Color fundus photograph · 50° FOV · 1924x1556px: 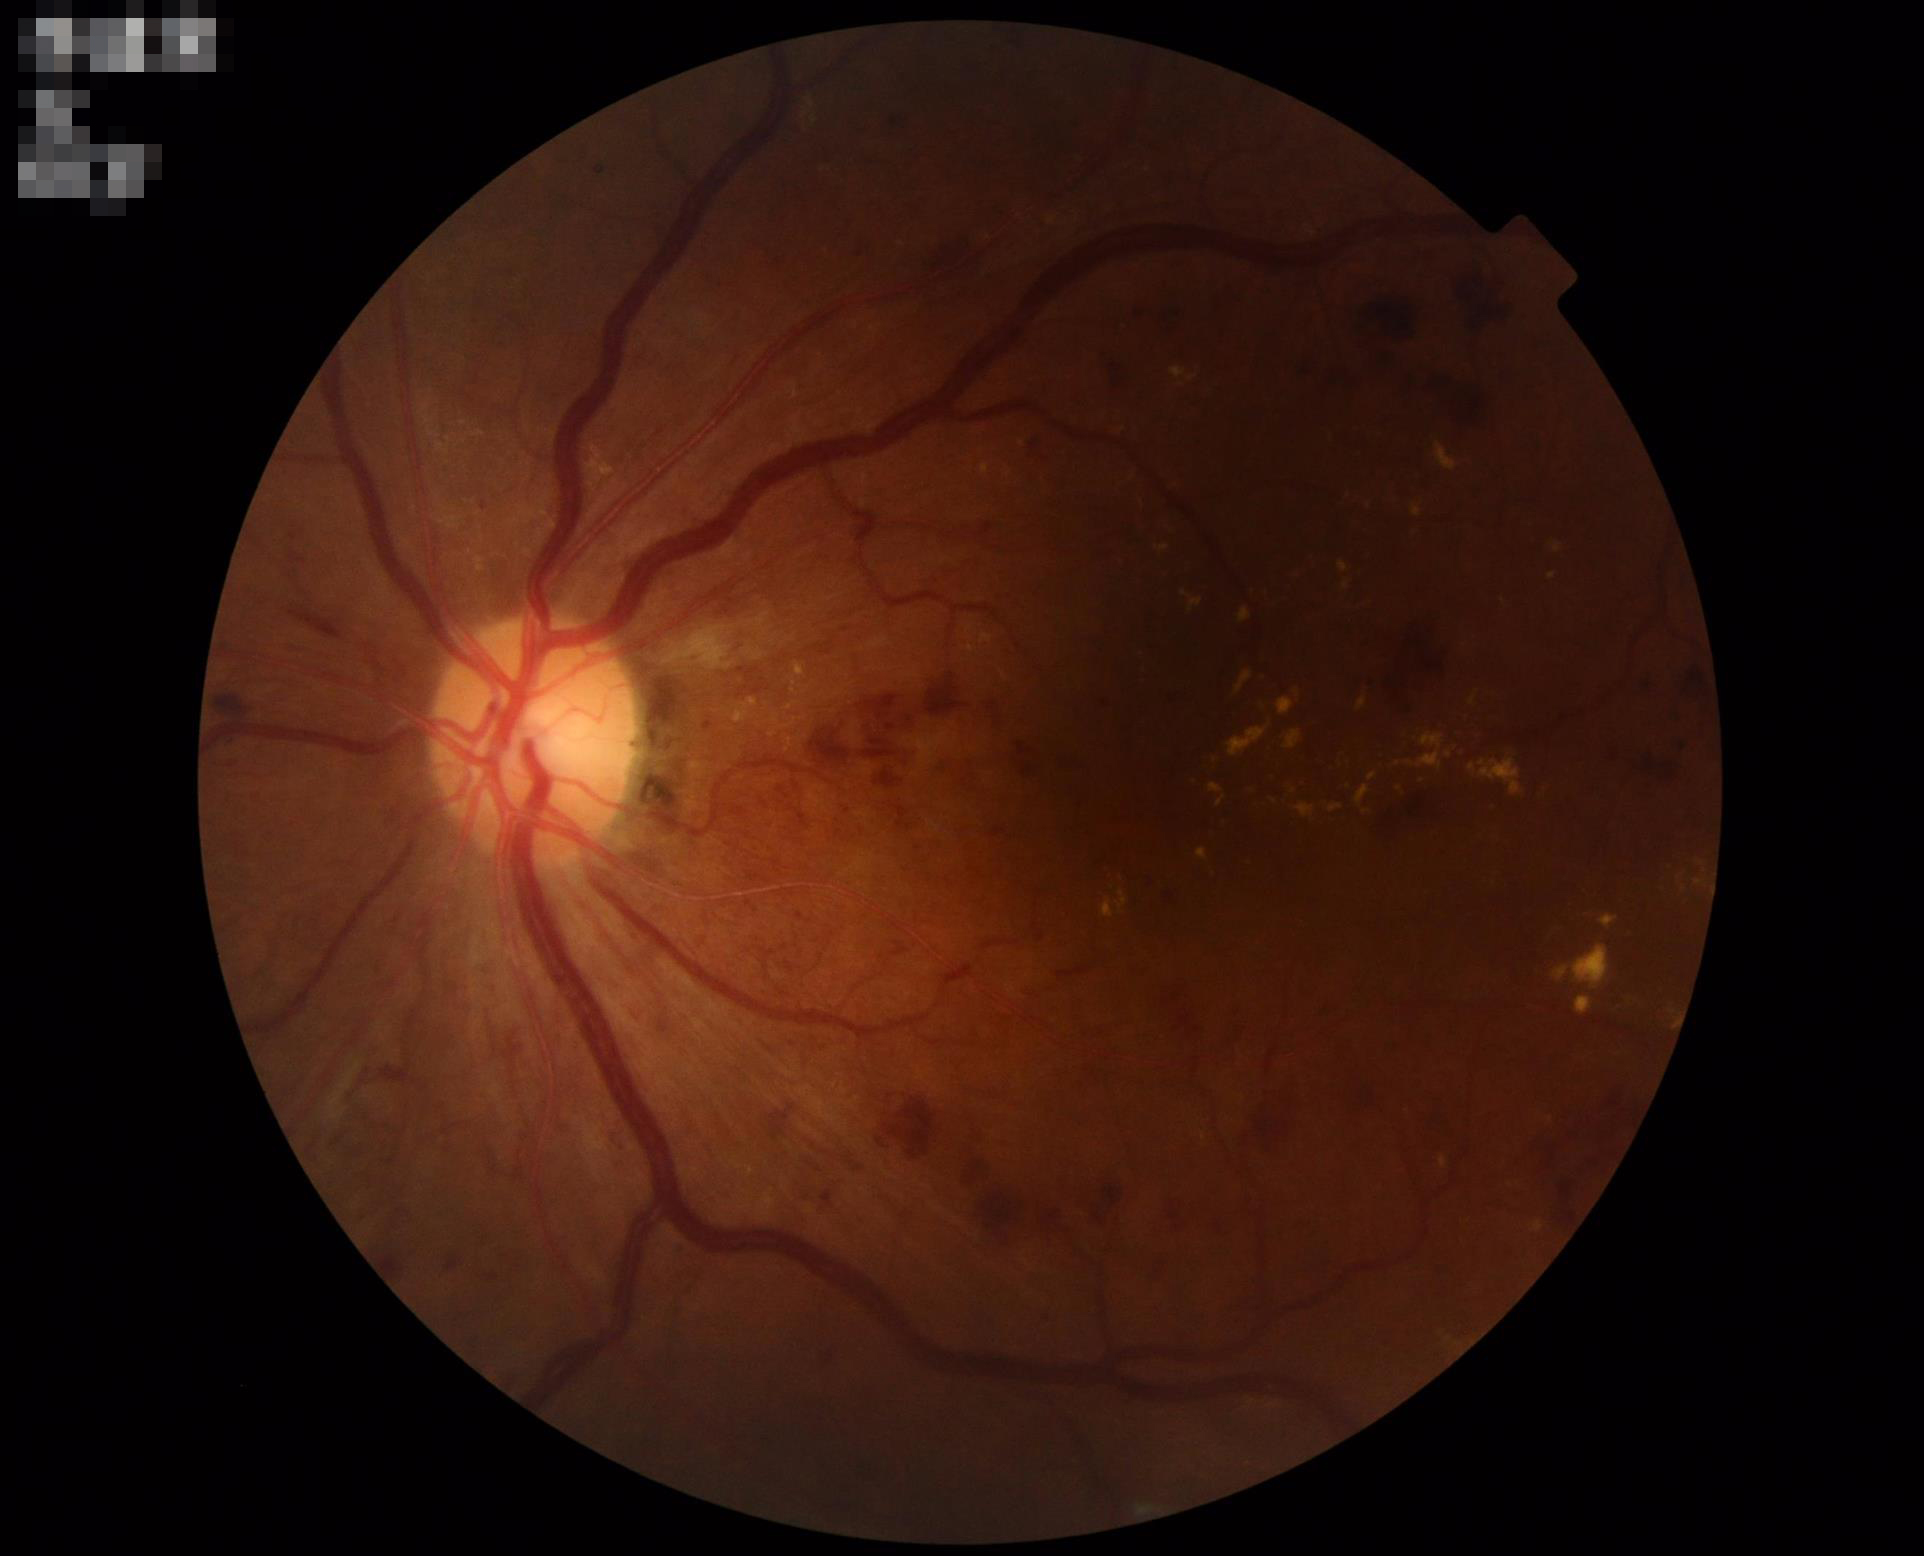 There is over- or under-exposure or a color cast. Overall image quality is good. Adequate contrast for distinguishing structures.